848x848px. Without pupil dilation. FOV: 45 degrees.
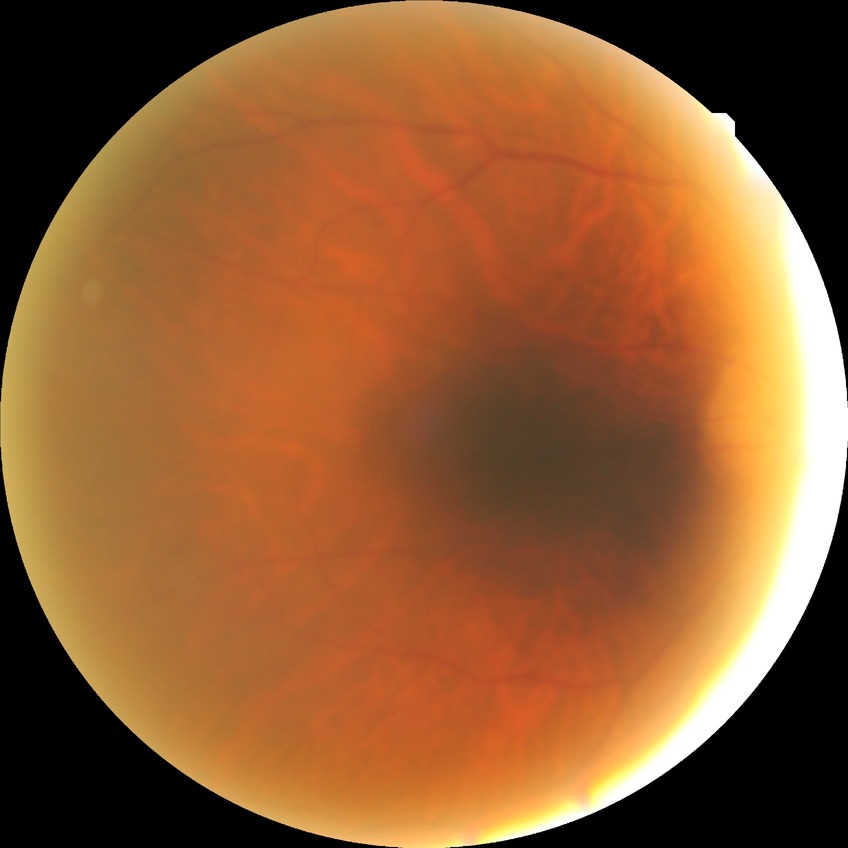
Diabetic retinopathy (DR) is no diabetic retinopathy (NDR).